FOV: 45 degrees.
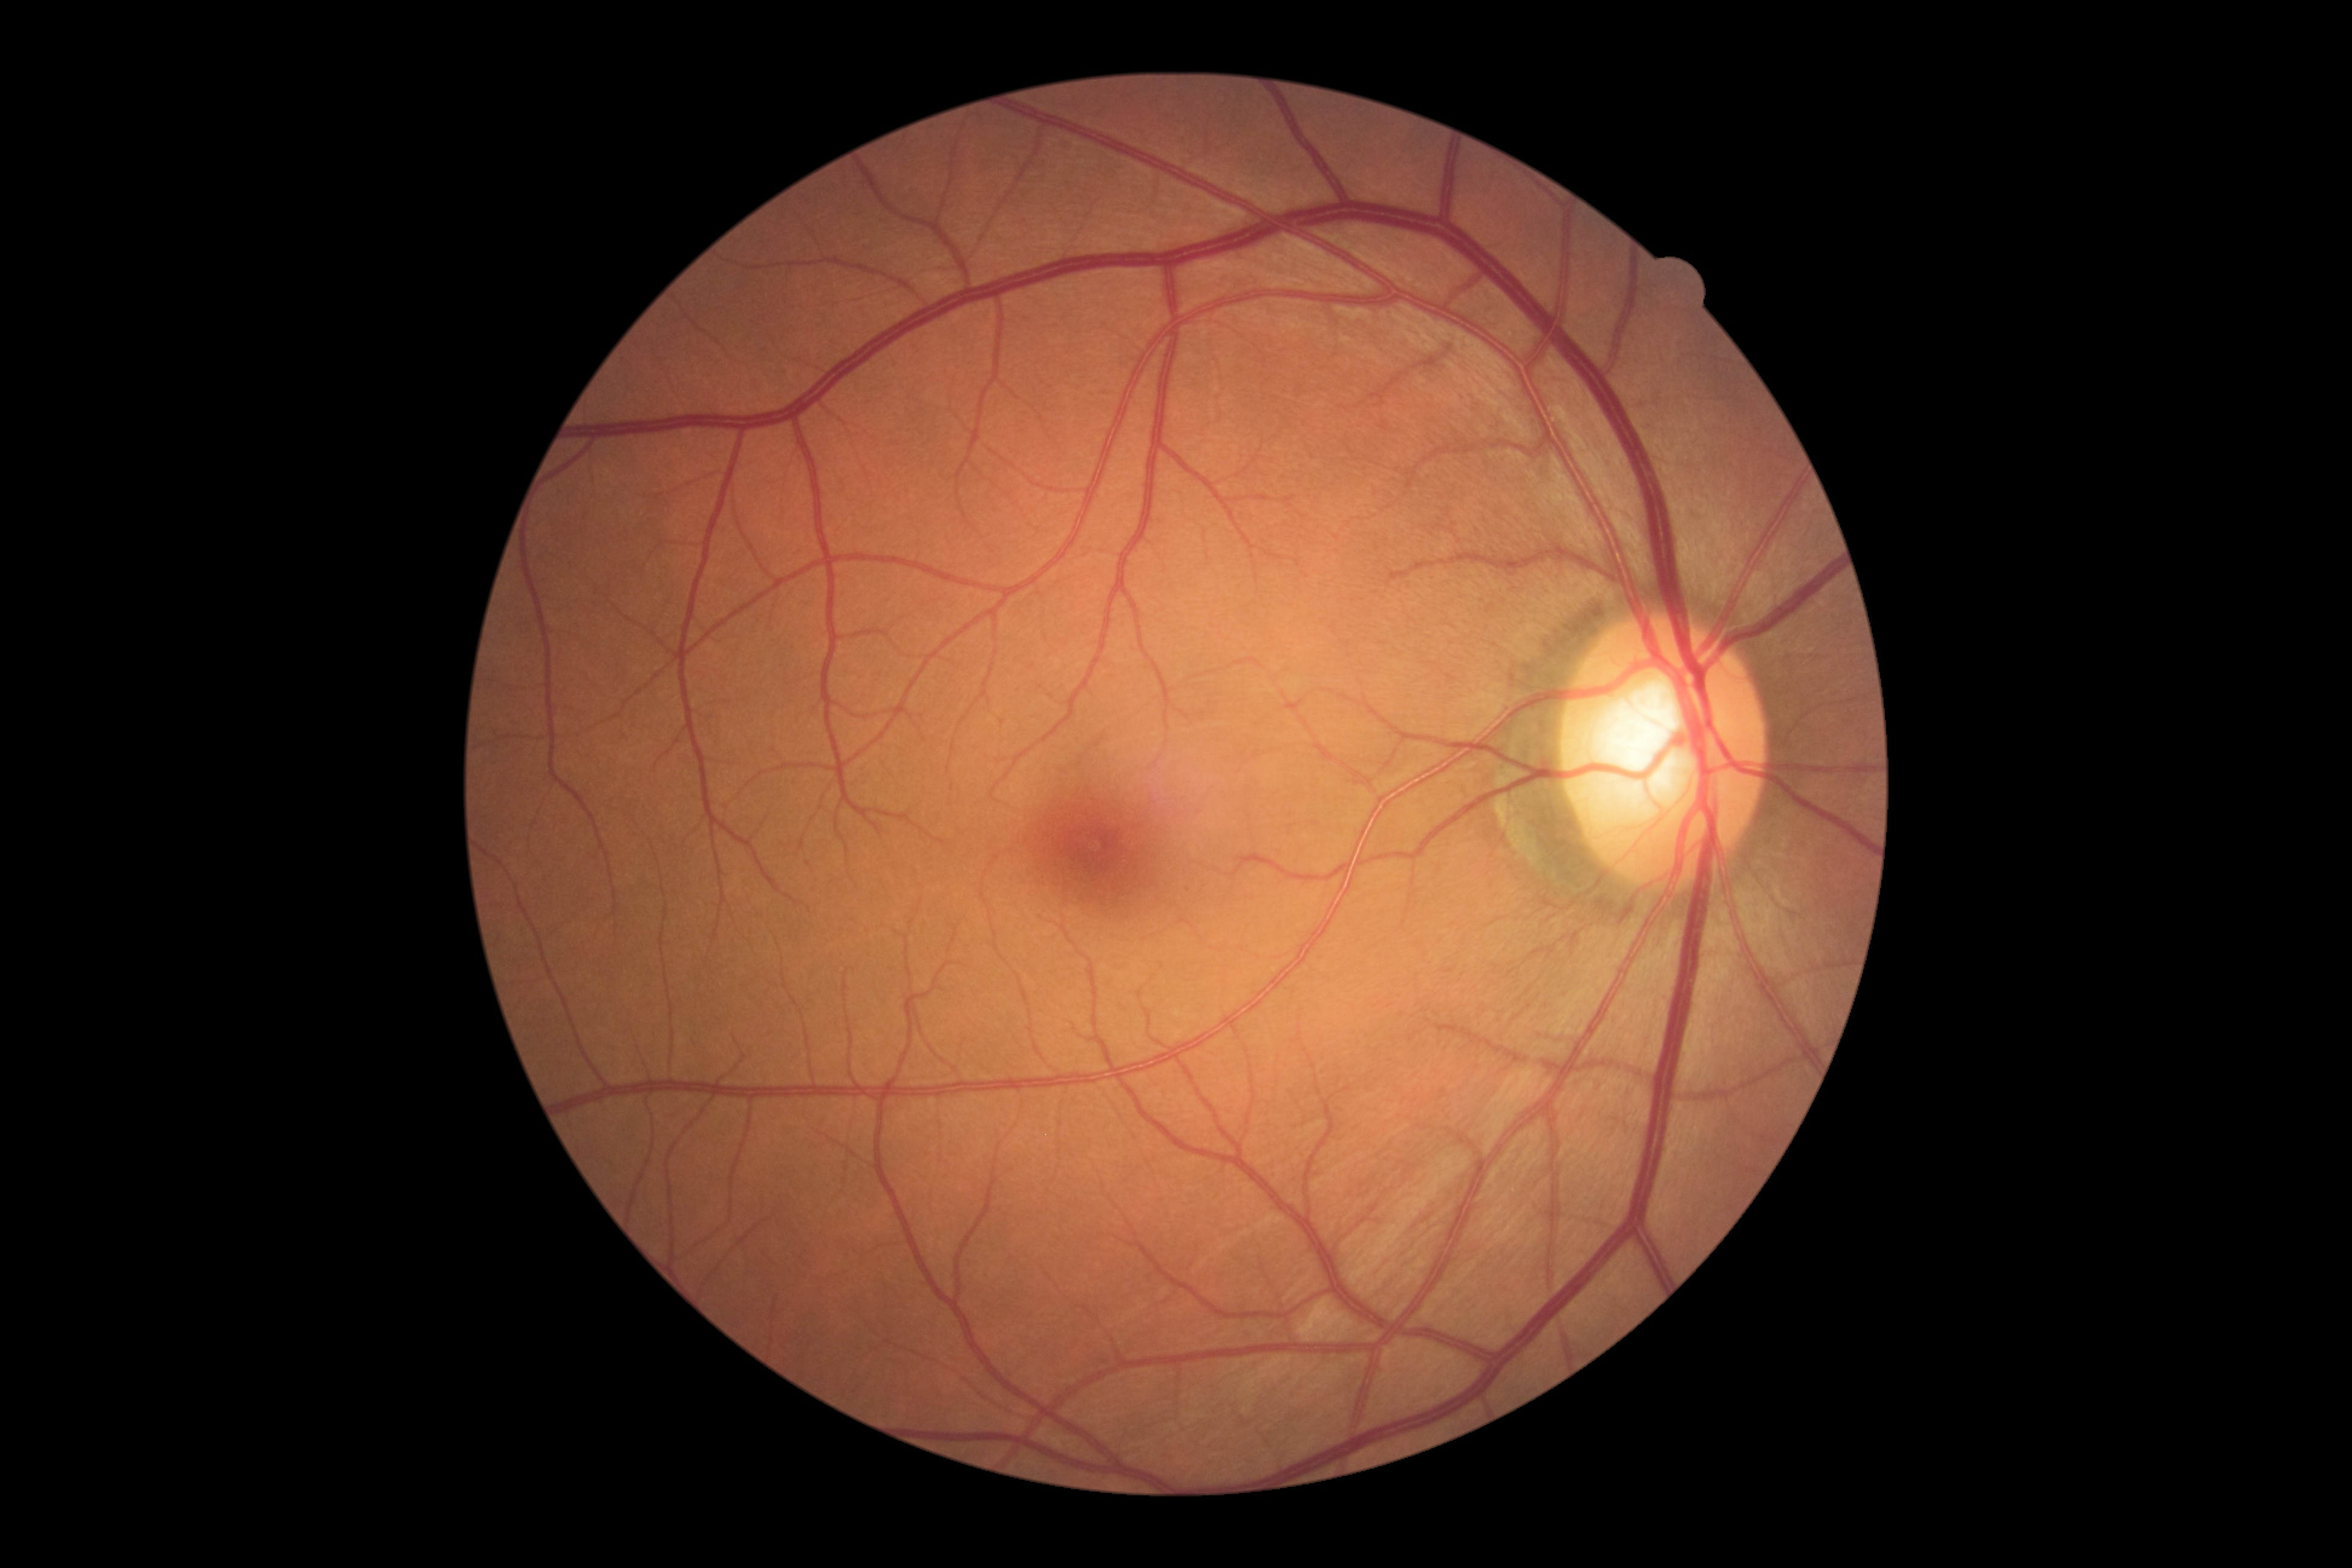
No signs of diabetic retinopathy.
Diabetic retinopathy (DR) is no apparent diabetic retinopathy (grade 0).